Color fundus image, FOV: 45 degrees: 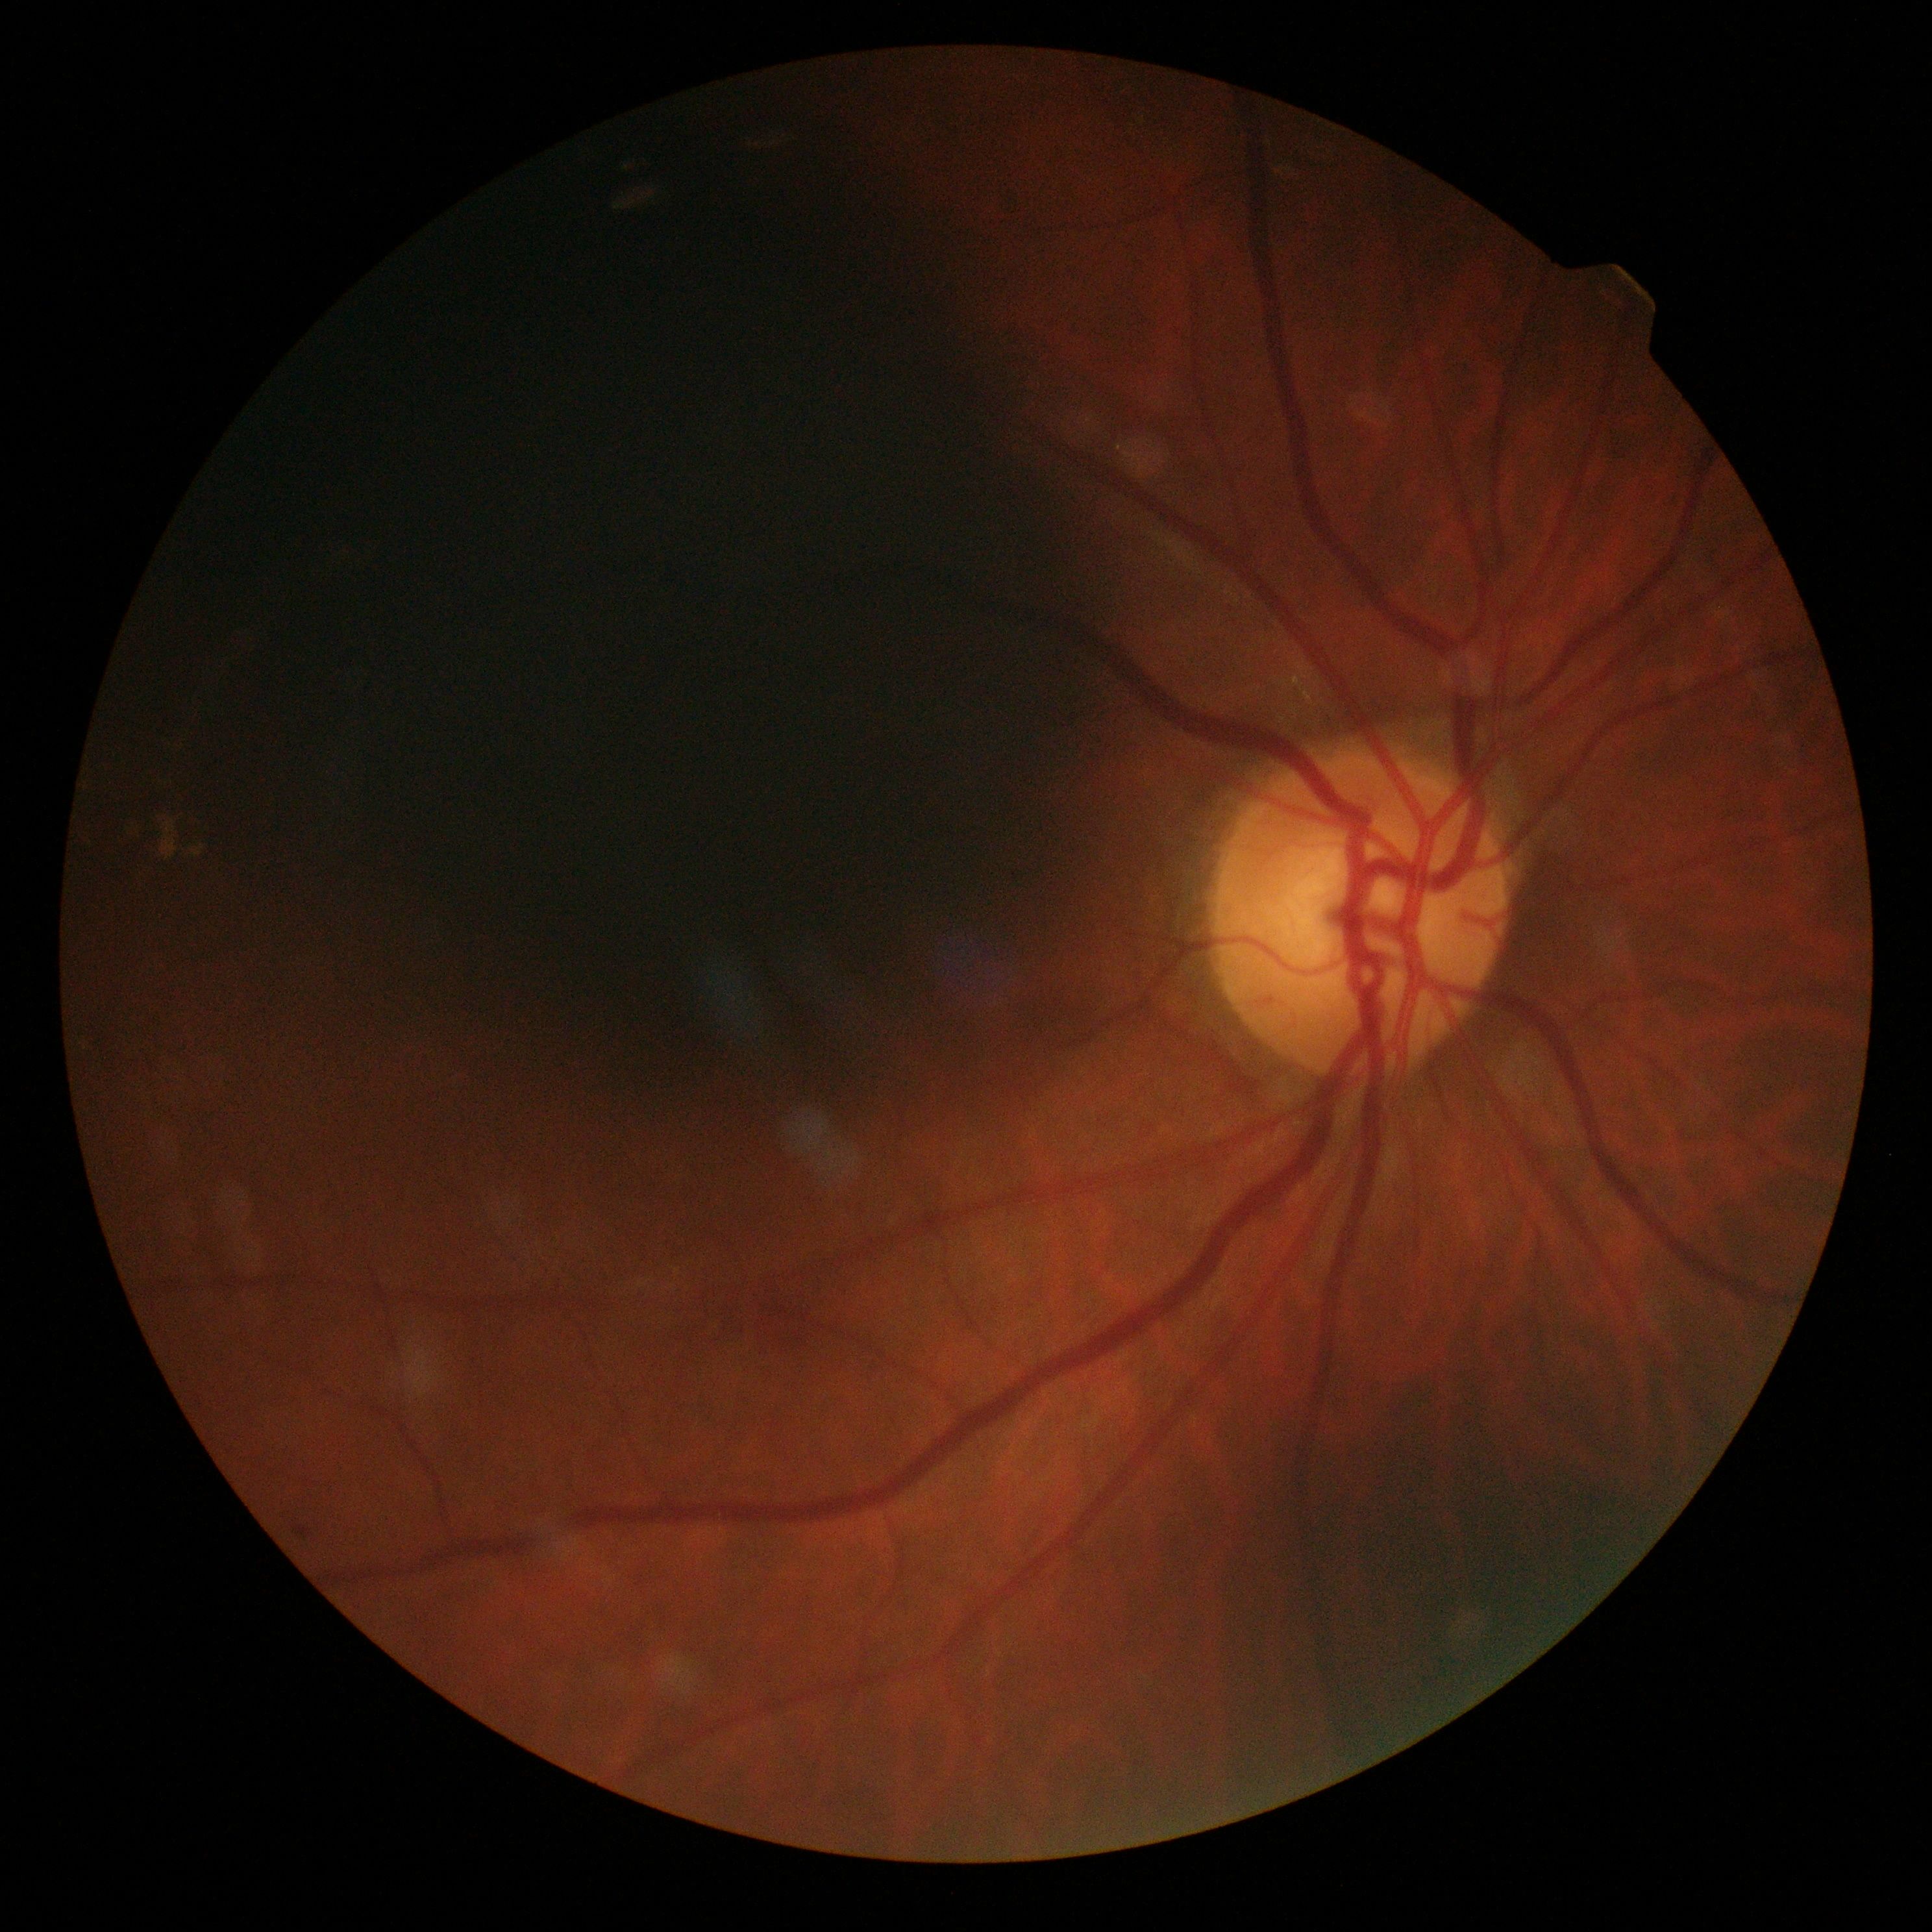
Retinopathy grade: 2 (moderate NPDR).